2352x1568 · 45° field of view — 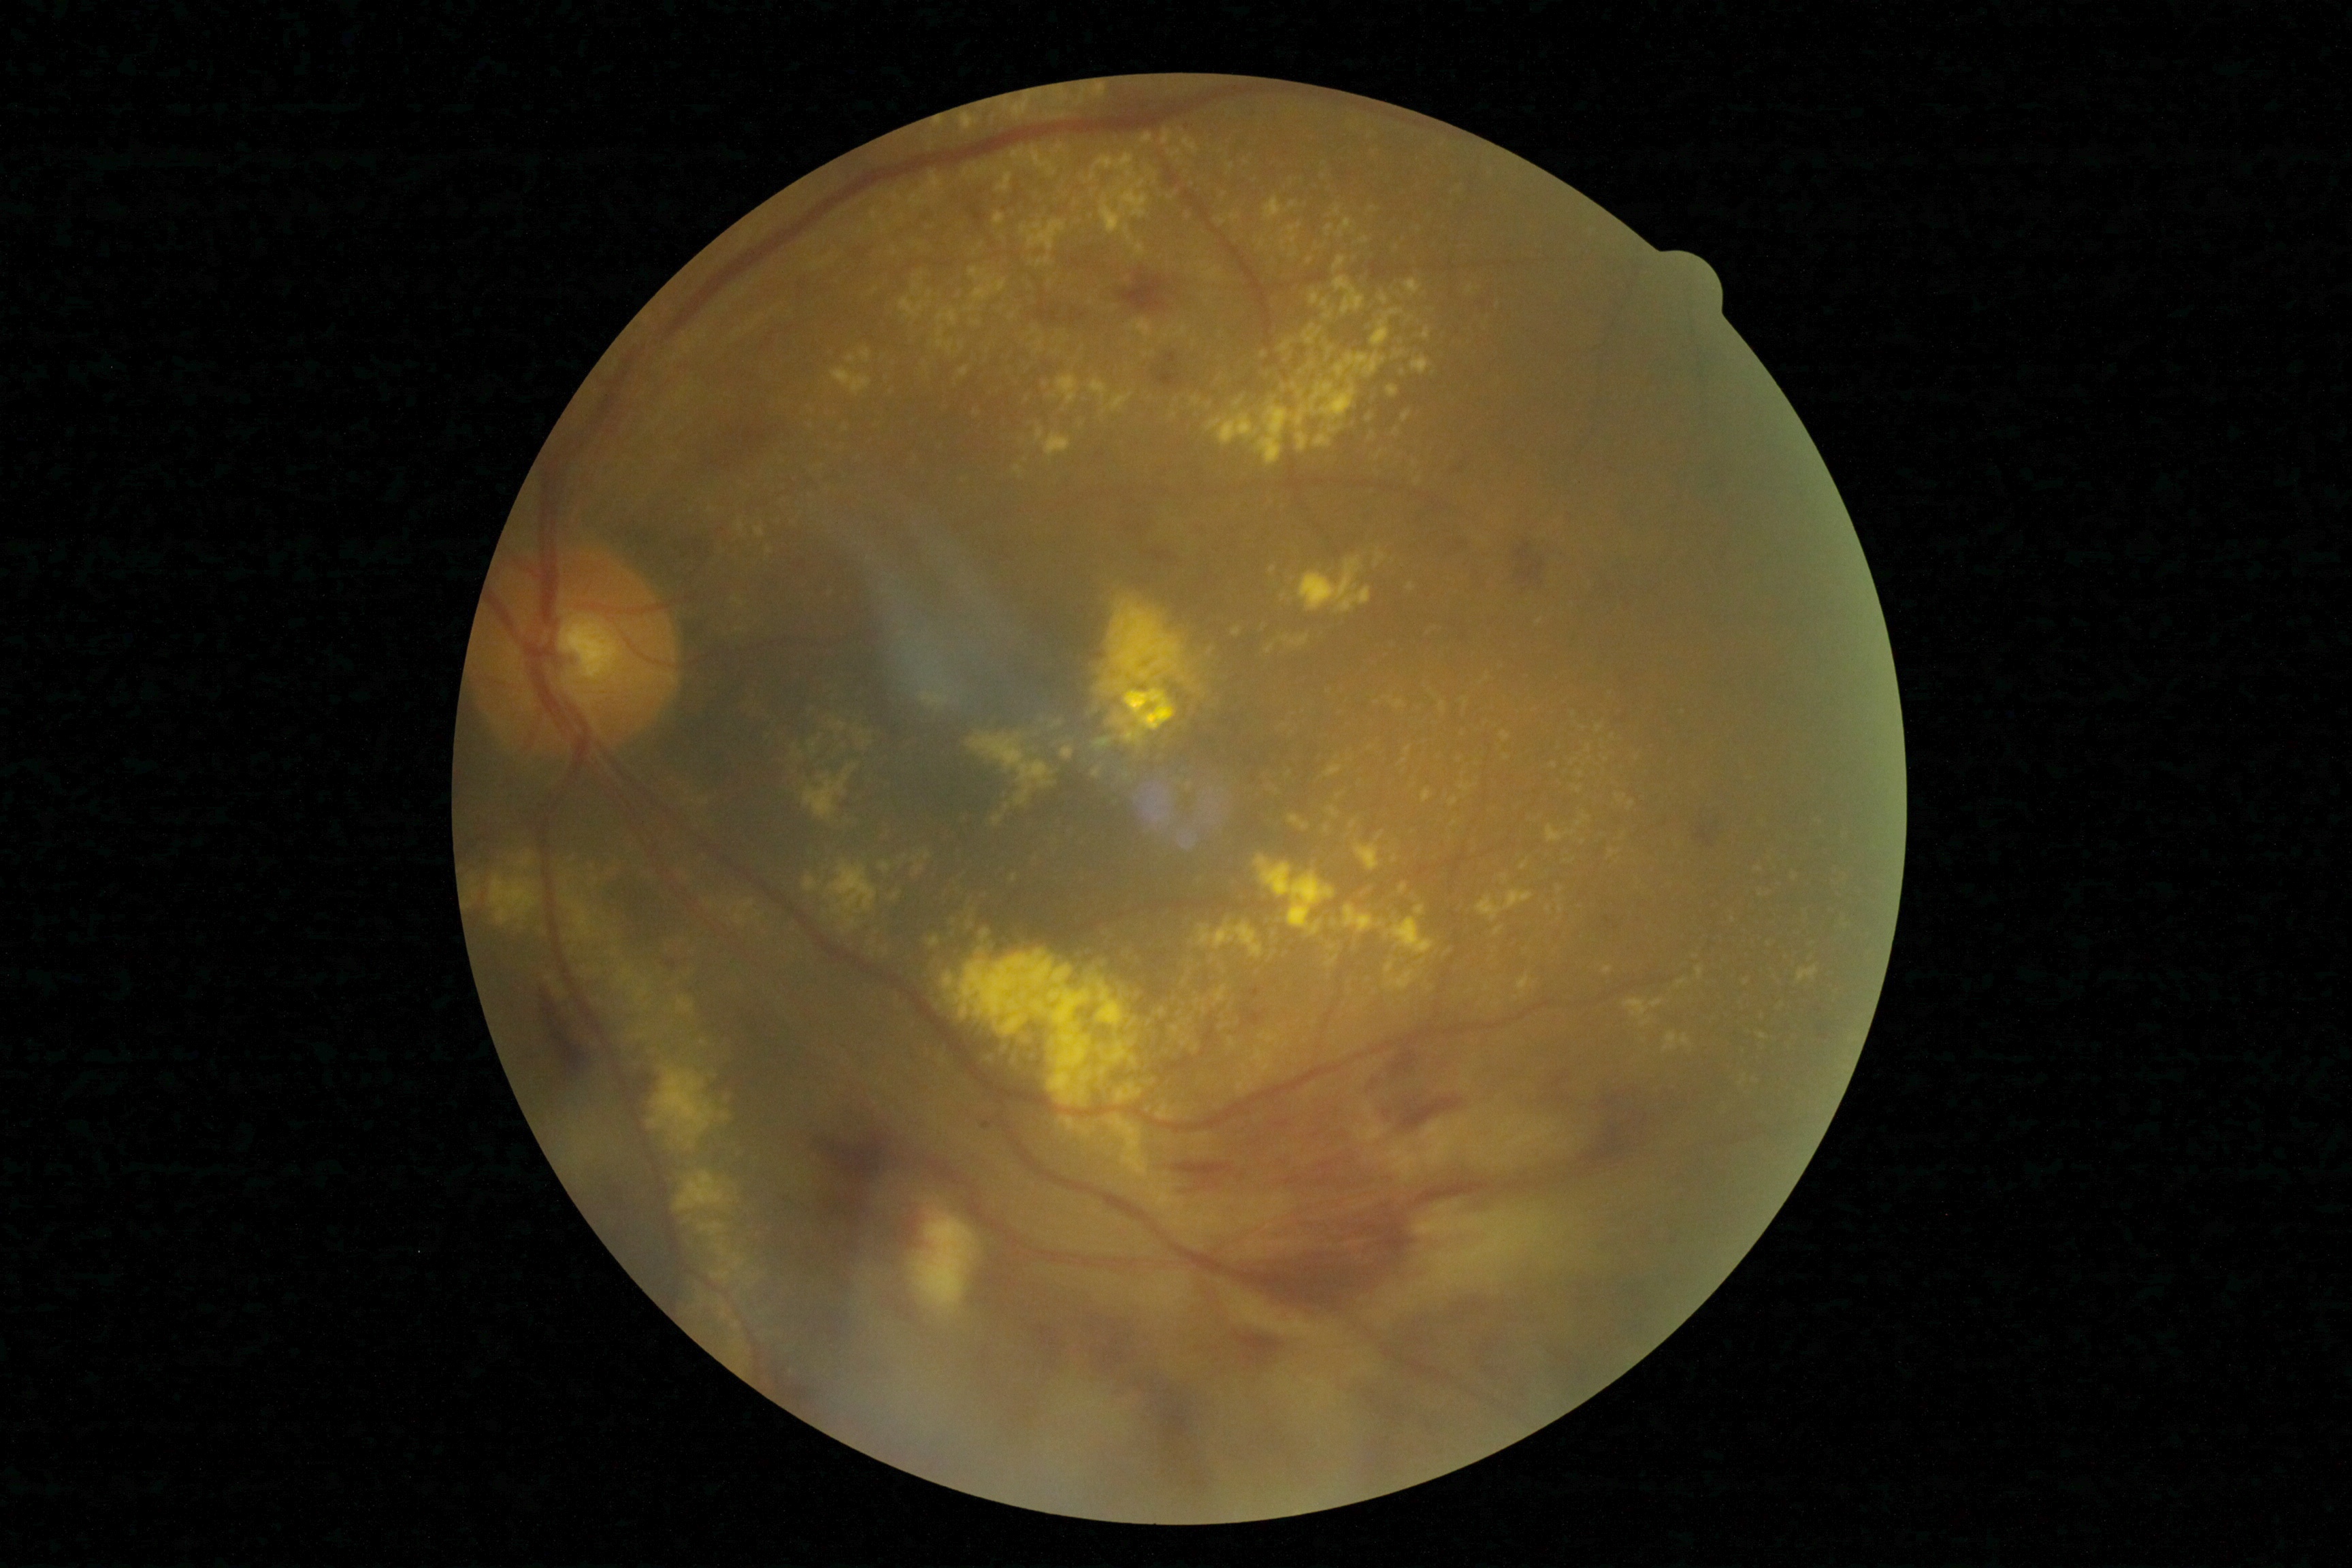 DR class: non-proliferative diabetic retinopathy, diabetic retinopathy: moderate non-proliferative diabetic retinopathy (grade 2).